CFP:
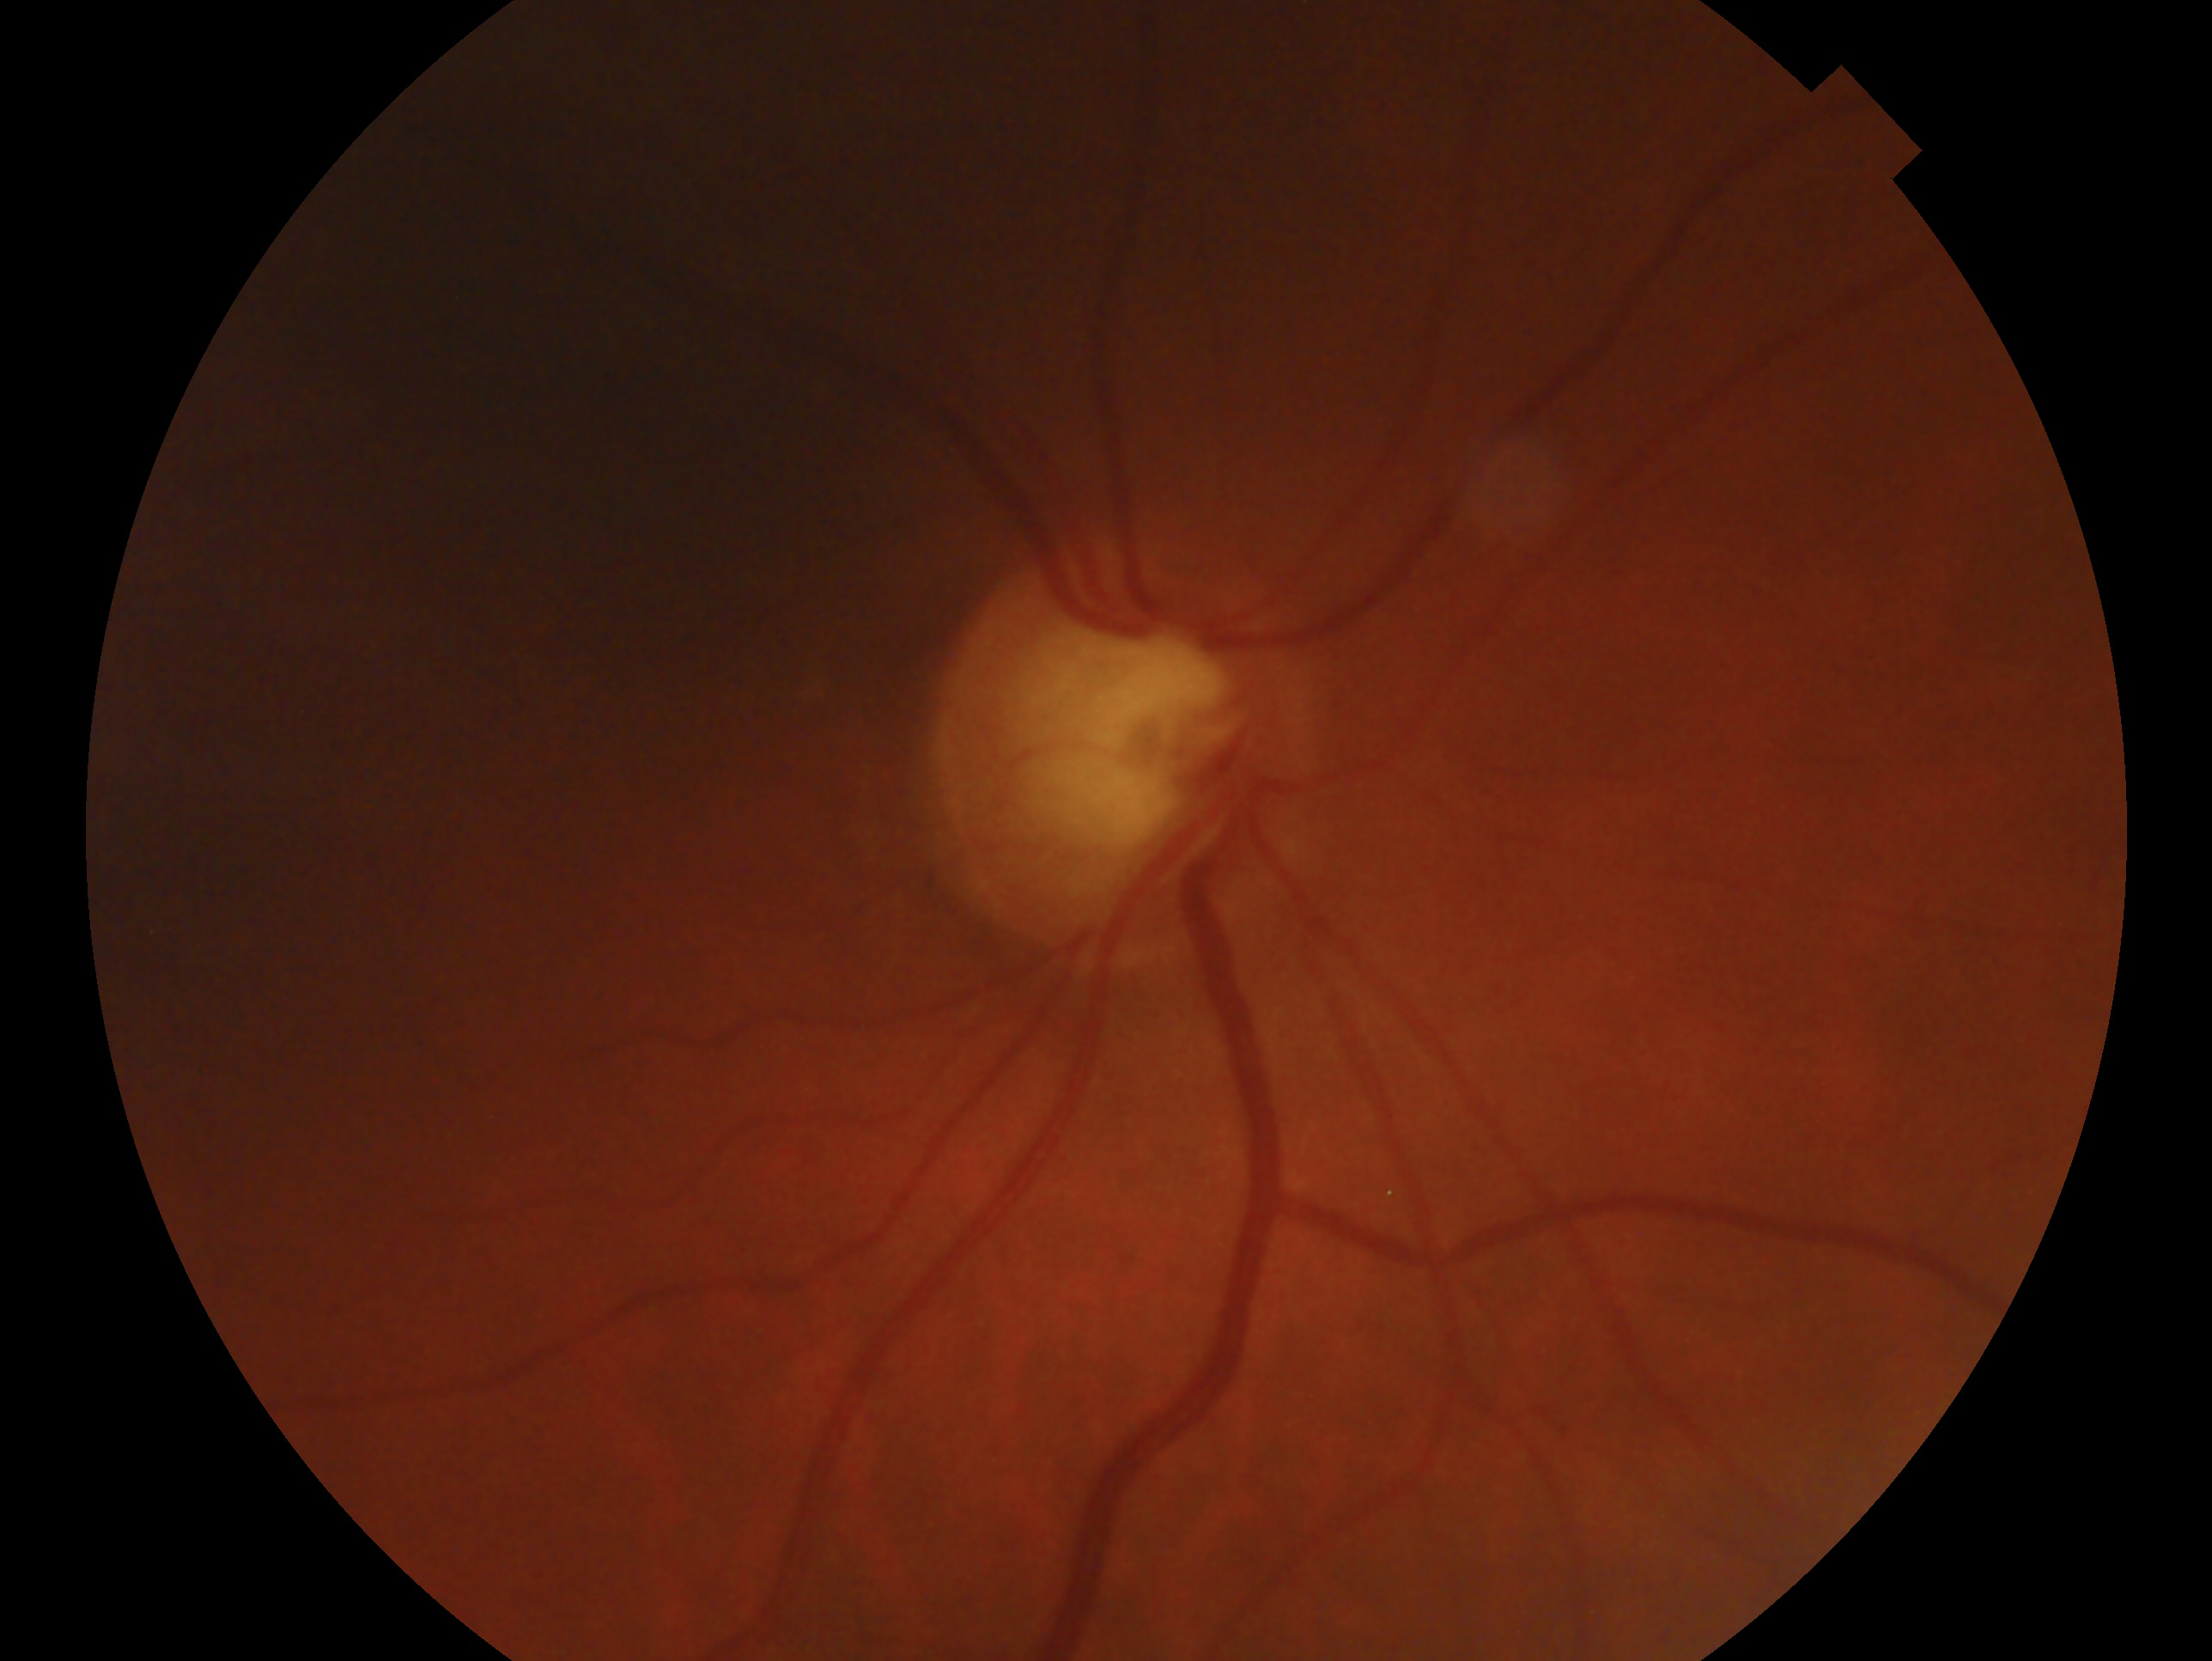
Assessment — glaucoma.
The image shows the right eye.